1440 by 1080 pixels; pediatric retinal photograph (wide-field); acquired on the Natus RetCam Envision — 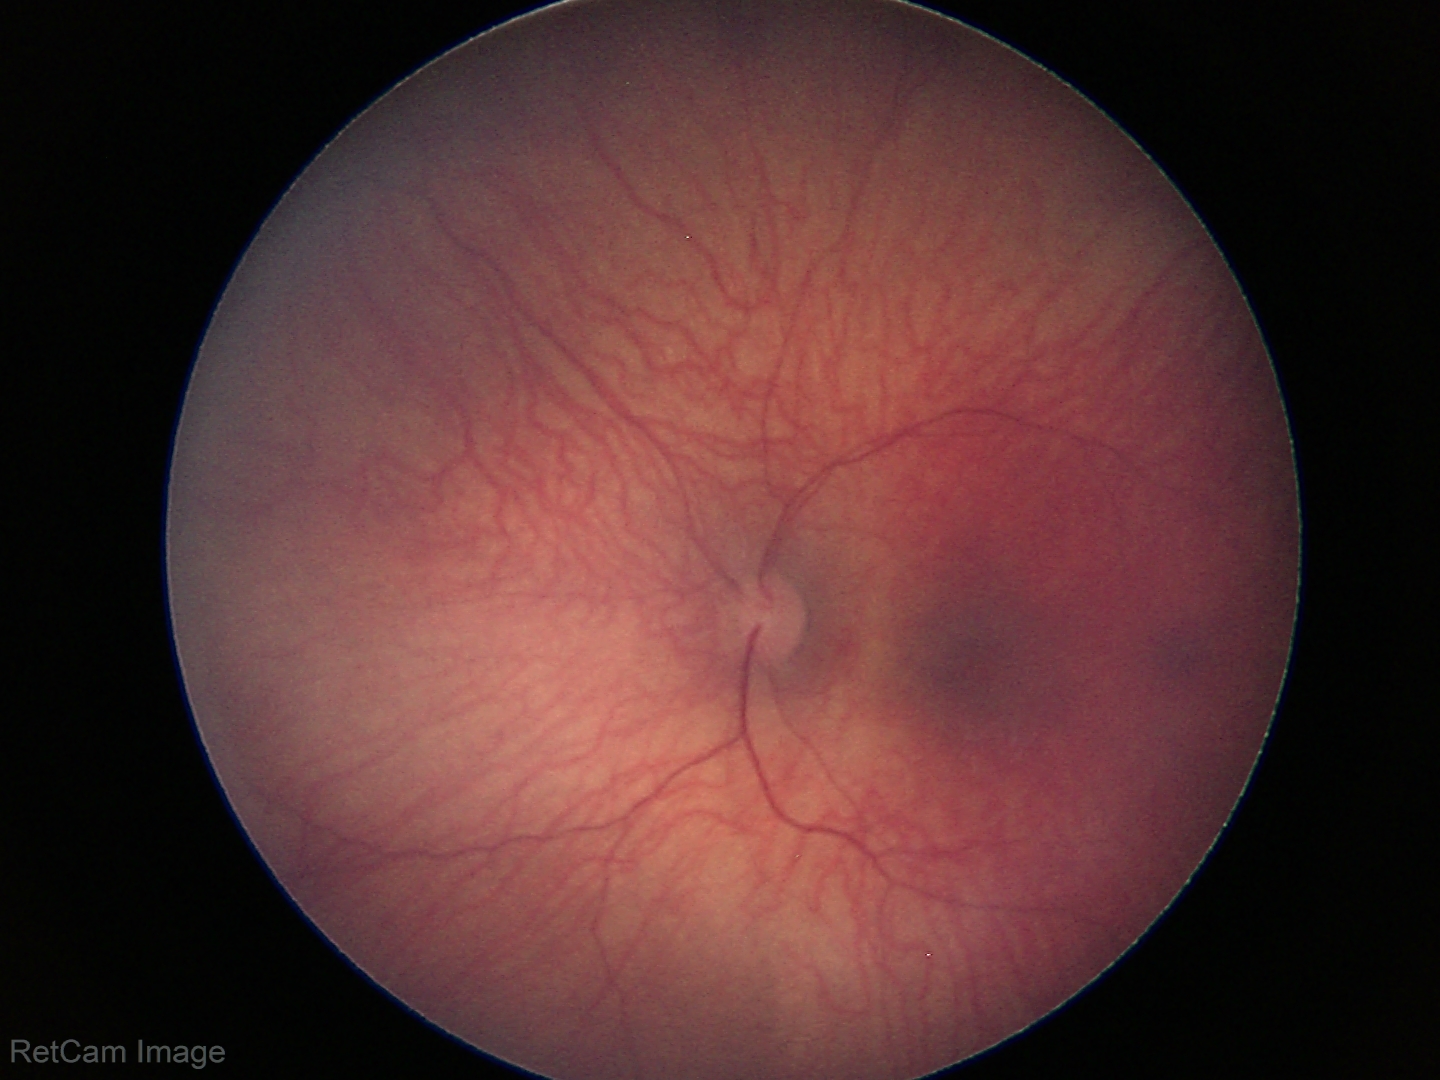

Normal screening examination.